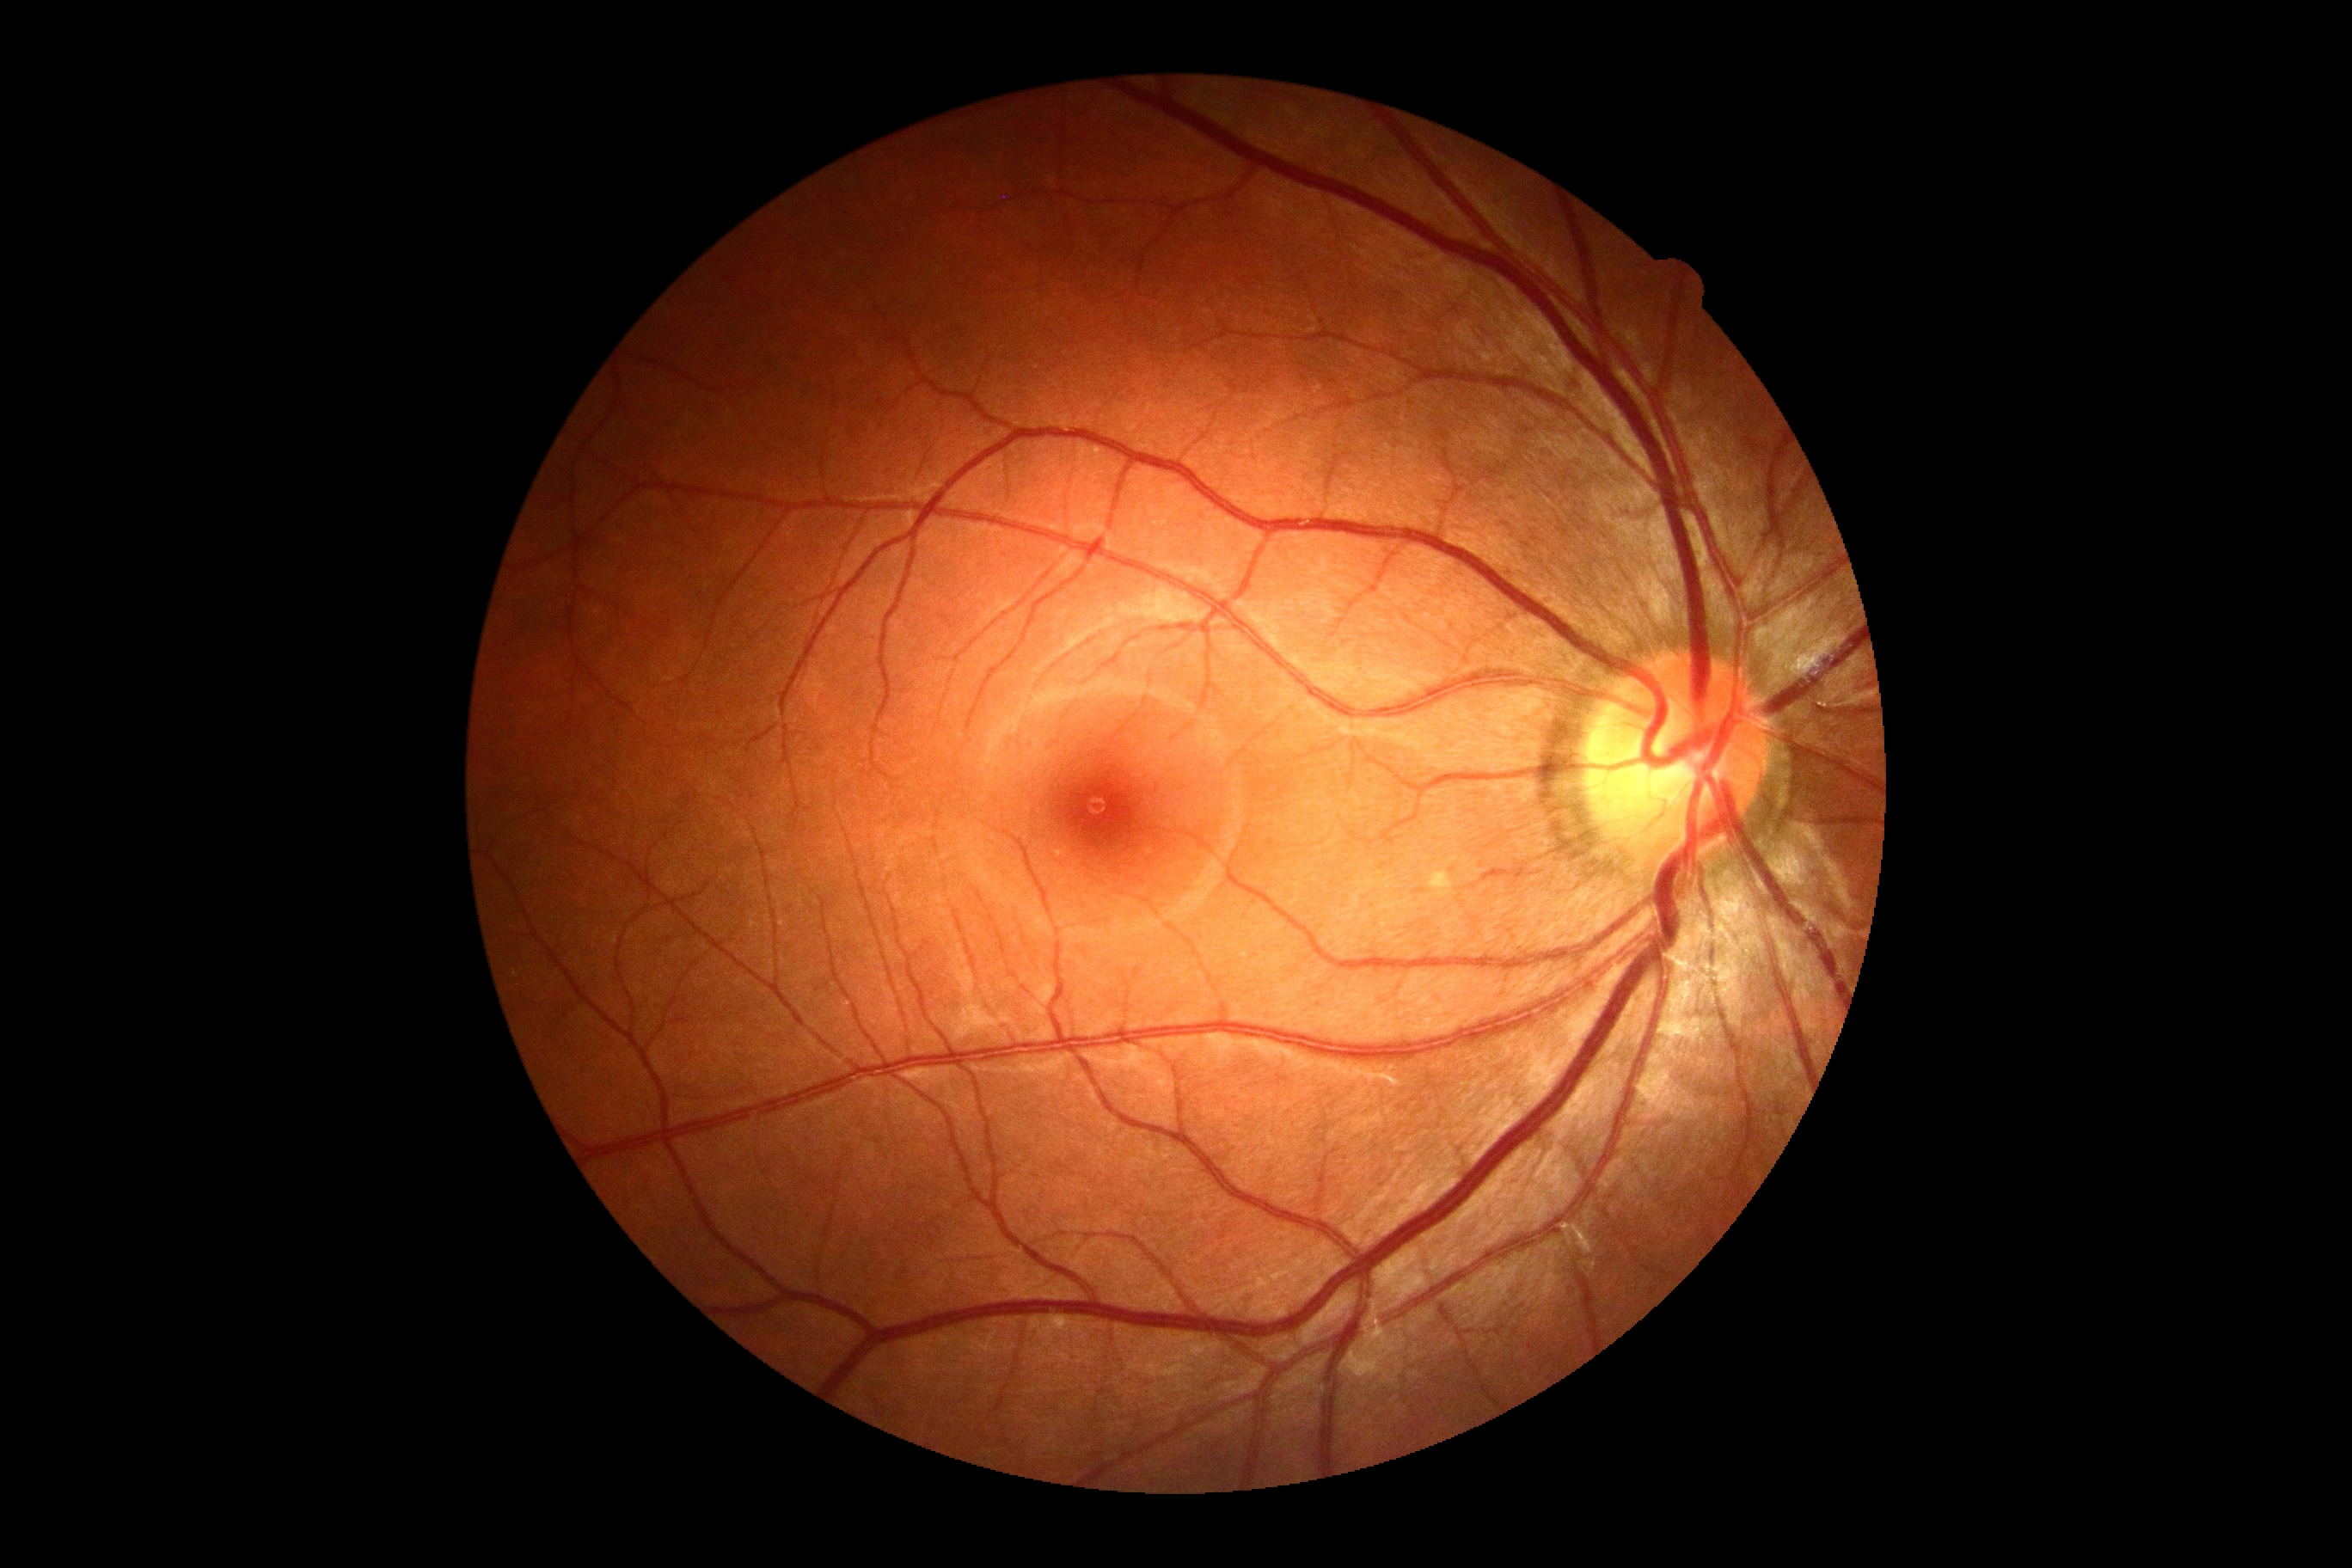

DR severity=no apparent diabetic retinopathy (grade 0).